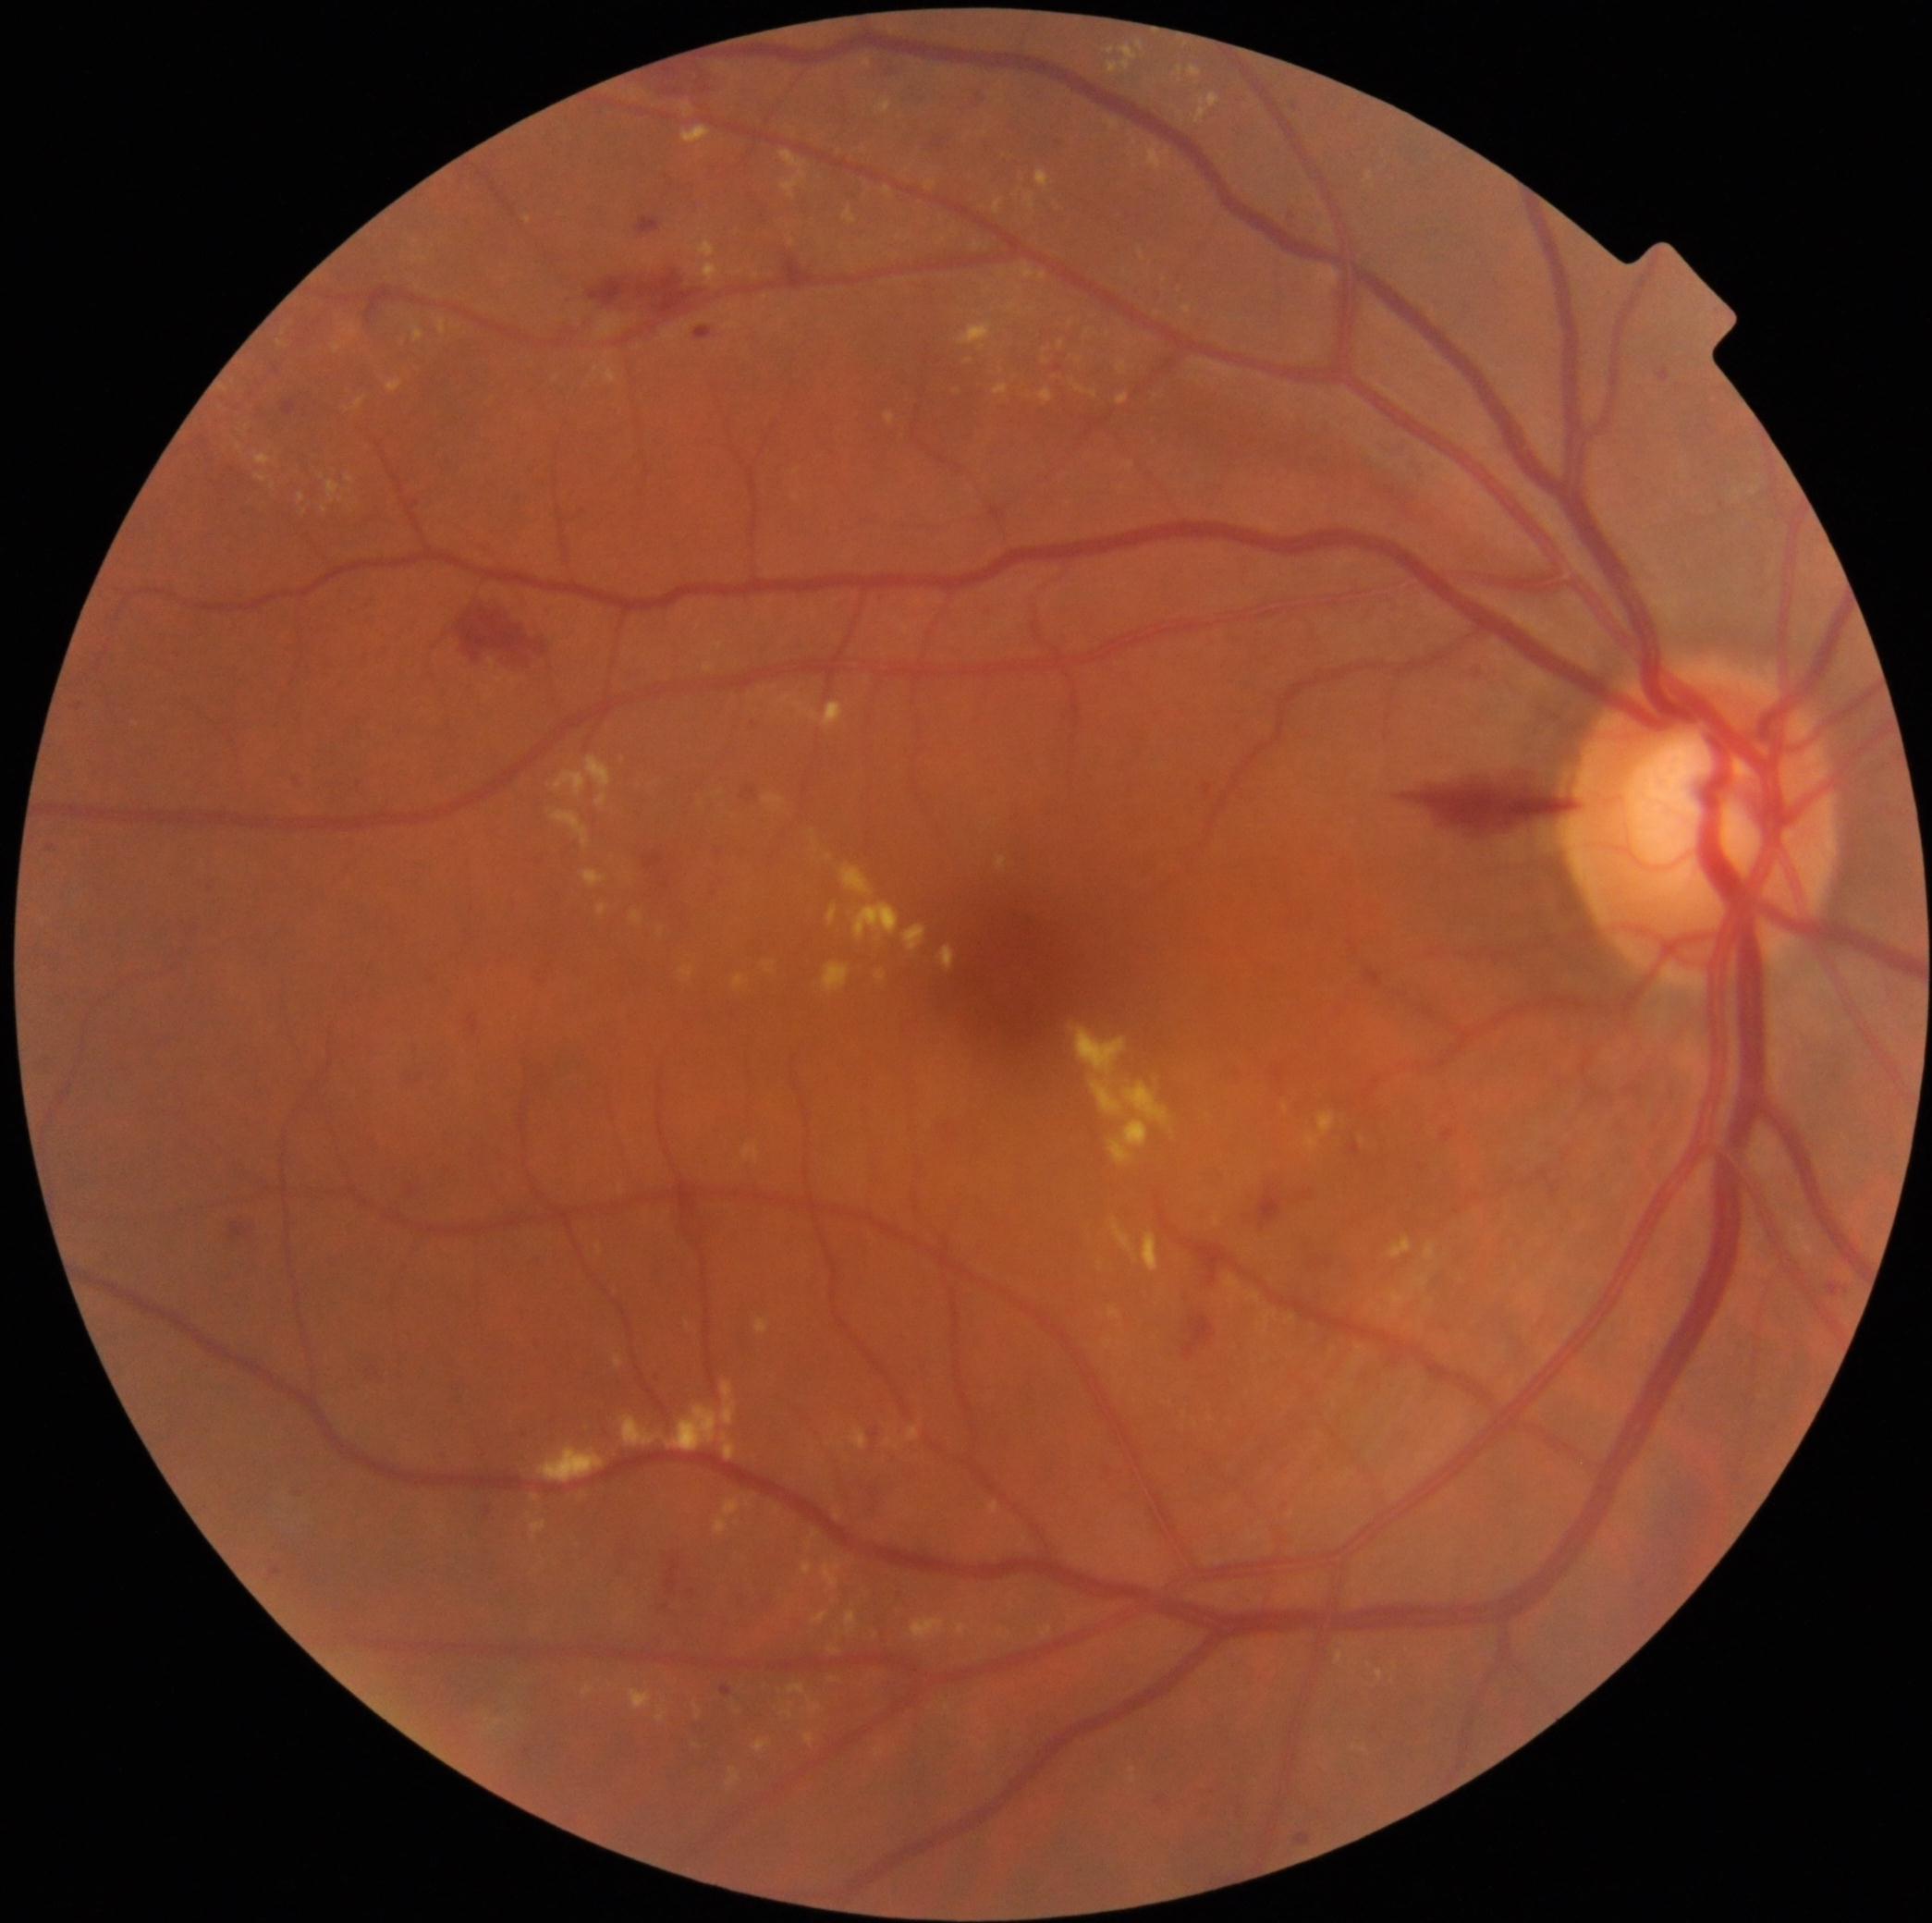
Diabetic retinopathy (DR) is 2
Lesions identified (partial list):
soft exudates (SEs): none
hard exudates (EXs) (more not shown): l=828, t=905, r=838, b=925; l=837, t=1512, r=840, b=1521; l=793, t=703, r=844, b=729; l=1070, t=1024, r=1171, b=1165; l=715, t=643, r=724, b=650; l=793, t=493, r=801, b=500; l=583, t=869, r=607, b=888; l=703, t=263, r=722, b=282; l=598, t=905, r=609, b=916; l=804, t=1732, r=815, b=1745; l=1007, t=300, r=1020, b=313; l=696, t=1704, r=703, b=1717; l=1196, t=94, r=1220, b=124; l=728, t=1768, r=740, b=1786
Smaller EXs around (594, 380); (1129, 343); (1124, 489); (839, 1632); (322, 477)
microaneurysms (MAs) (more not shown): l=636, t=218, r=660, b=235; l=271, t=1567, r=282, b=1577; l=932, t=140, r=945, b=149; l=885, t=67, r=894, b=74; l=295, t=778, r=306, b=785; l=722, t=1685, r=731, b=1695; l=368, t=1364, r=383, b=1377; l=1297, t=1833, r=1312, b=1844; l=654, t=1371, r=658, b=1380; l=525, t=1747, r=531, b=1757; l=282, t=401, r=297, b=416; l=977, t=94, r=986, b=104; l=410, t=1185, r=415, b=1195; l=1441, t=1130, r=1454, b=1143; l=1156, t=1797, r=1164, b=1803
Smaller MAs around (489, 1512); (300, 1492)
hemorrhages (HEs): l=1408, t=774, r=1574, b=832; l=220, t=1214, r=261, b=1242; l=851, t=1423, r=877, b=1450; l=850, t=1476, r=888, b=1512; l=1182, t=1315, r=1217, b=1362; l=666, t=1554, r=691, b=1601; l=465, t=607, r=545, b=671; l=1258, t=1187, r=1286, b=1229; l=643, t=854, r=664, b=869; l=1192, t=1243, r=1237, b=1287; l=593, t=268, r=703, b=319; l=654, t=63, r=728, b=92; l=780, t=261, r=793, b=282